Fundus photo: 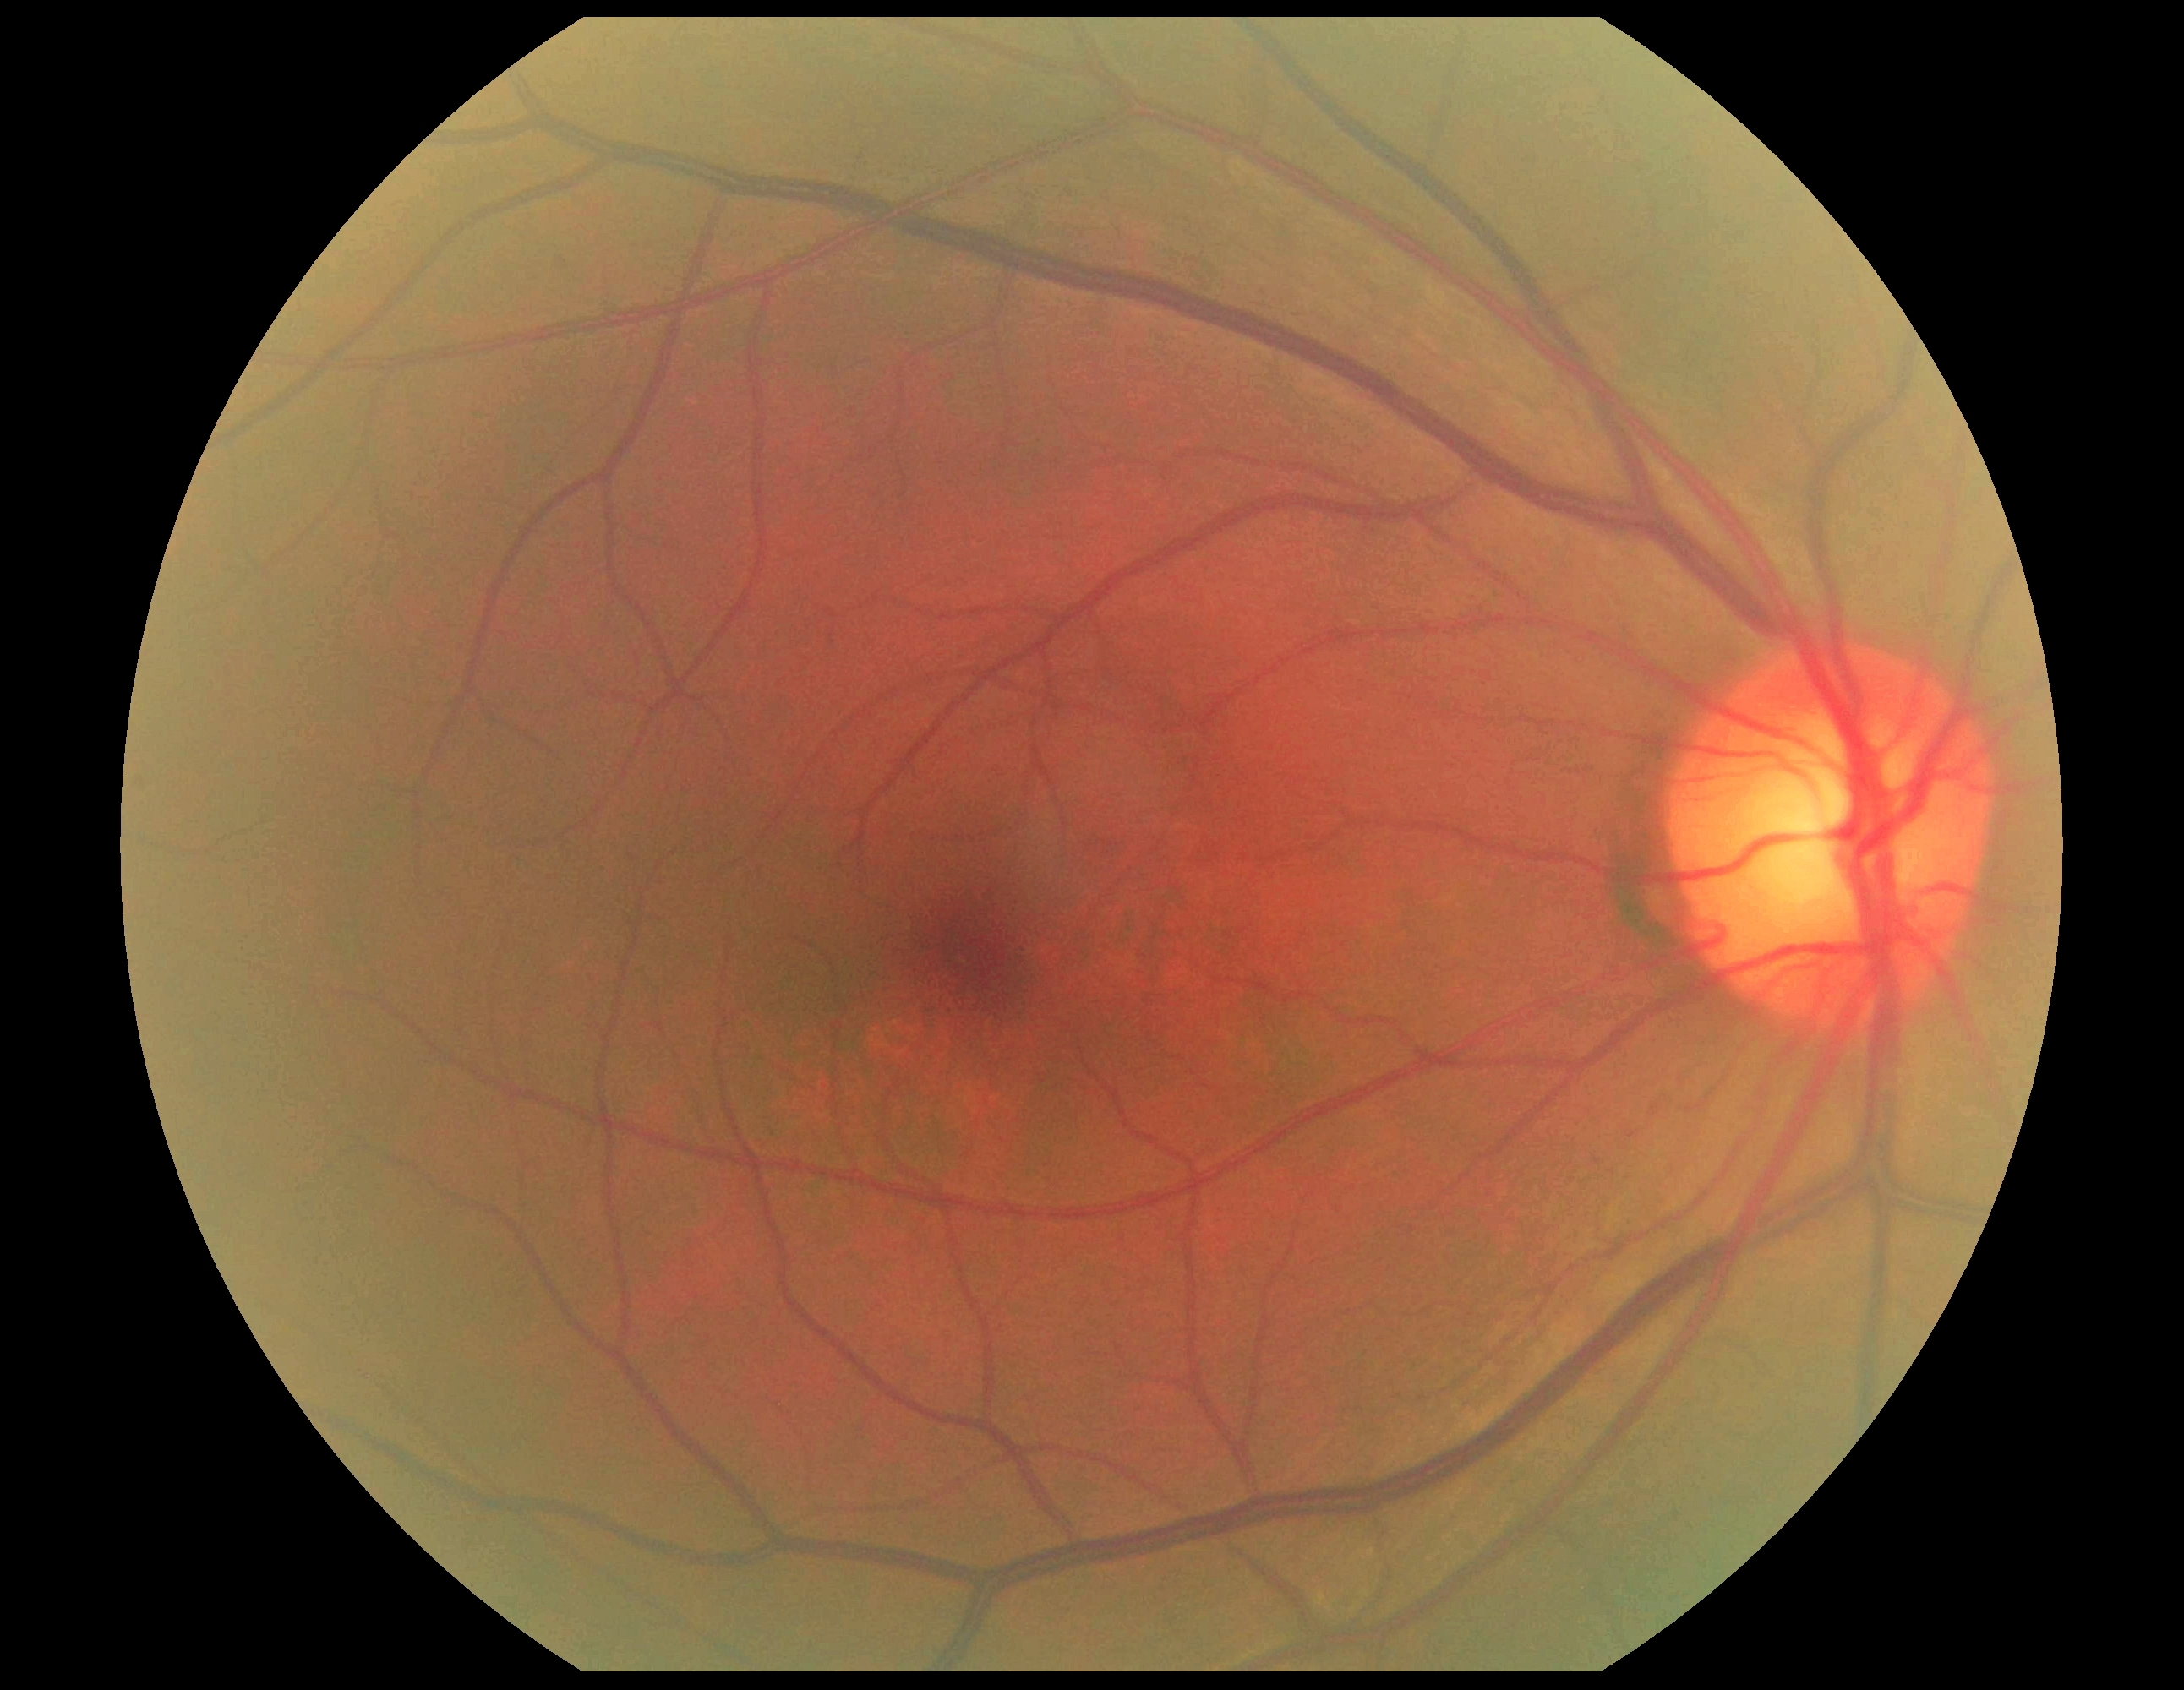 diabetic retinopathy severity = grade 0 (no apparent retinopathy)